45° field of view, color fundus image — 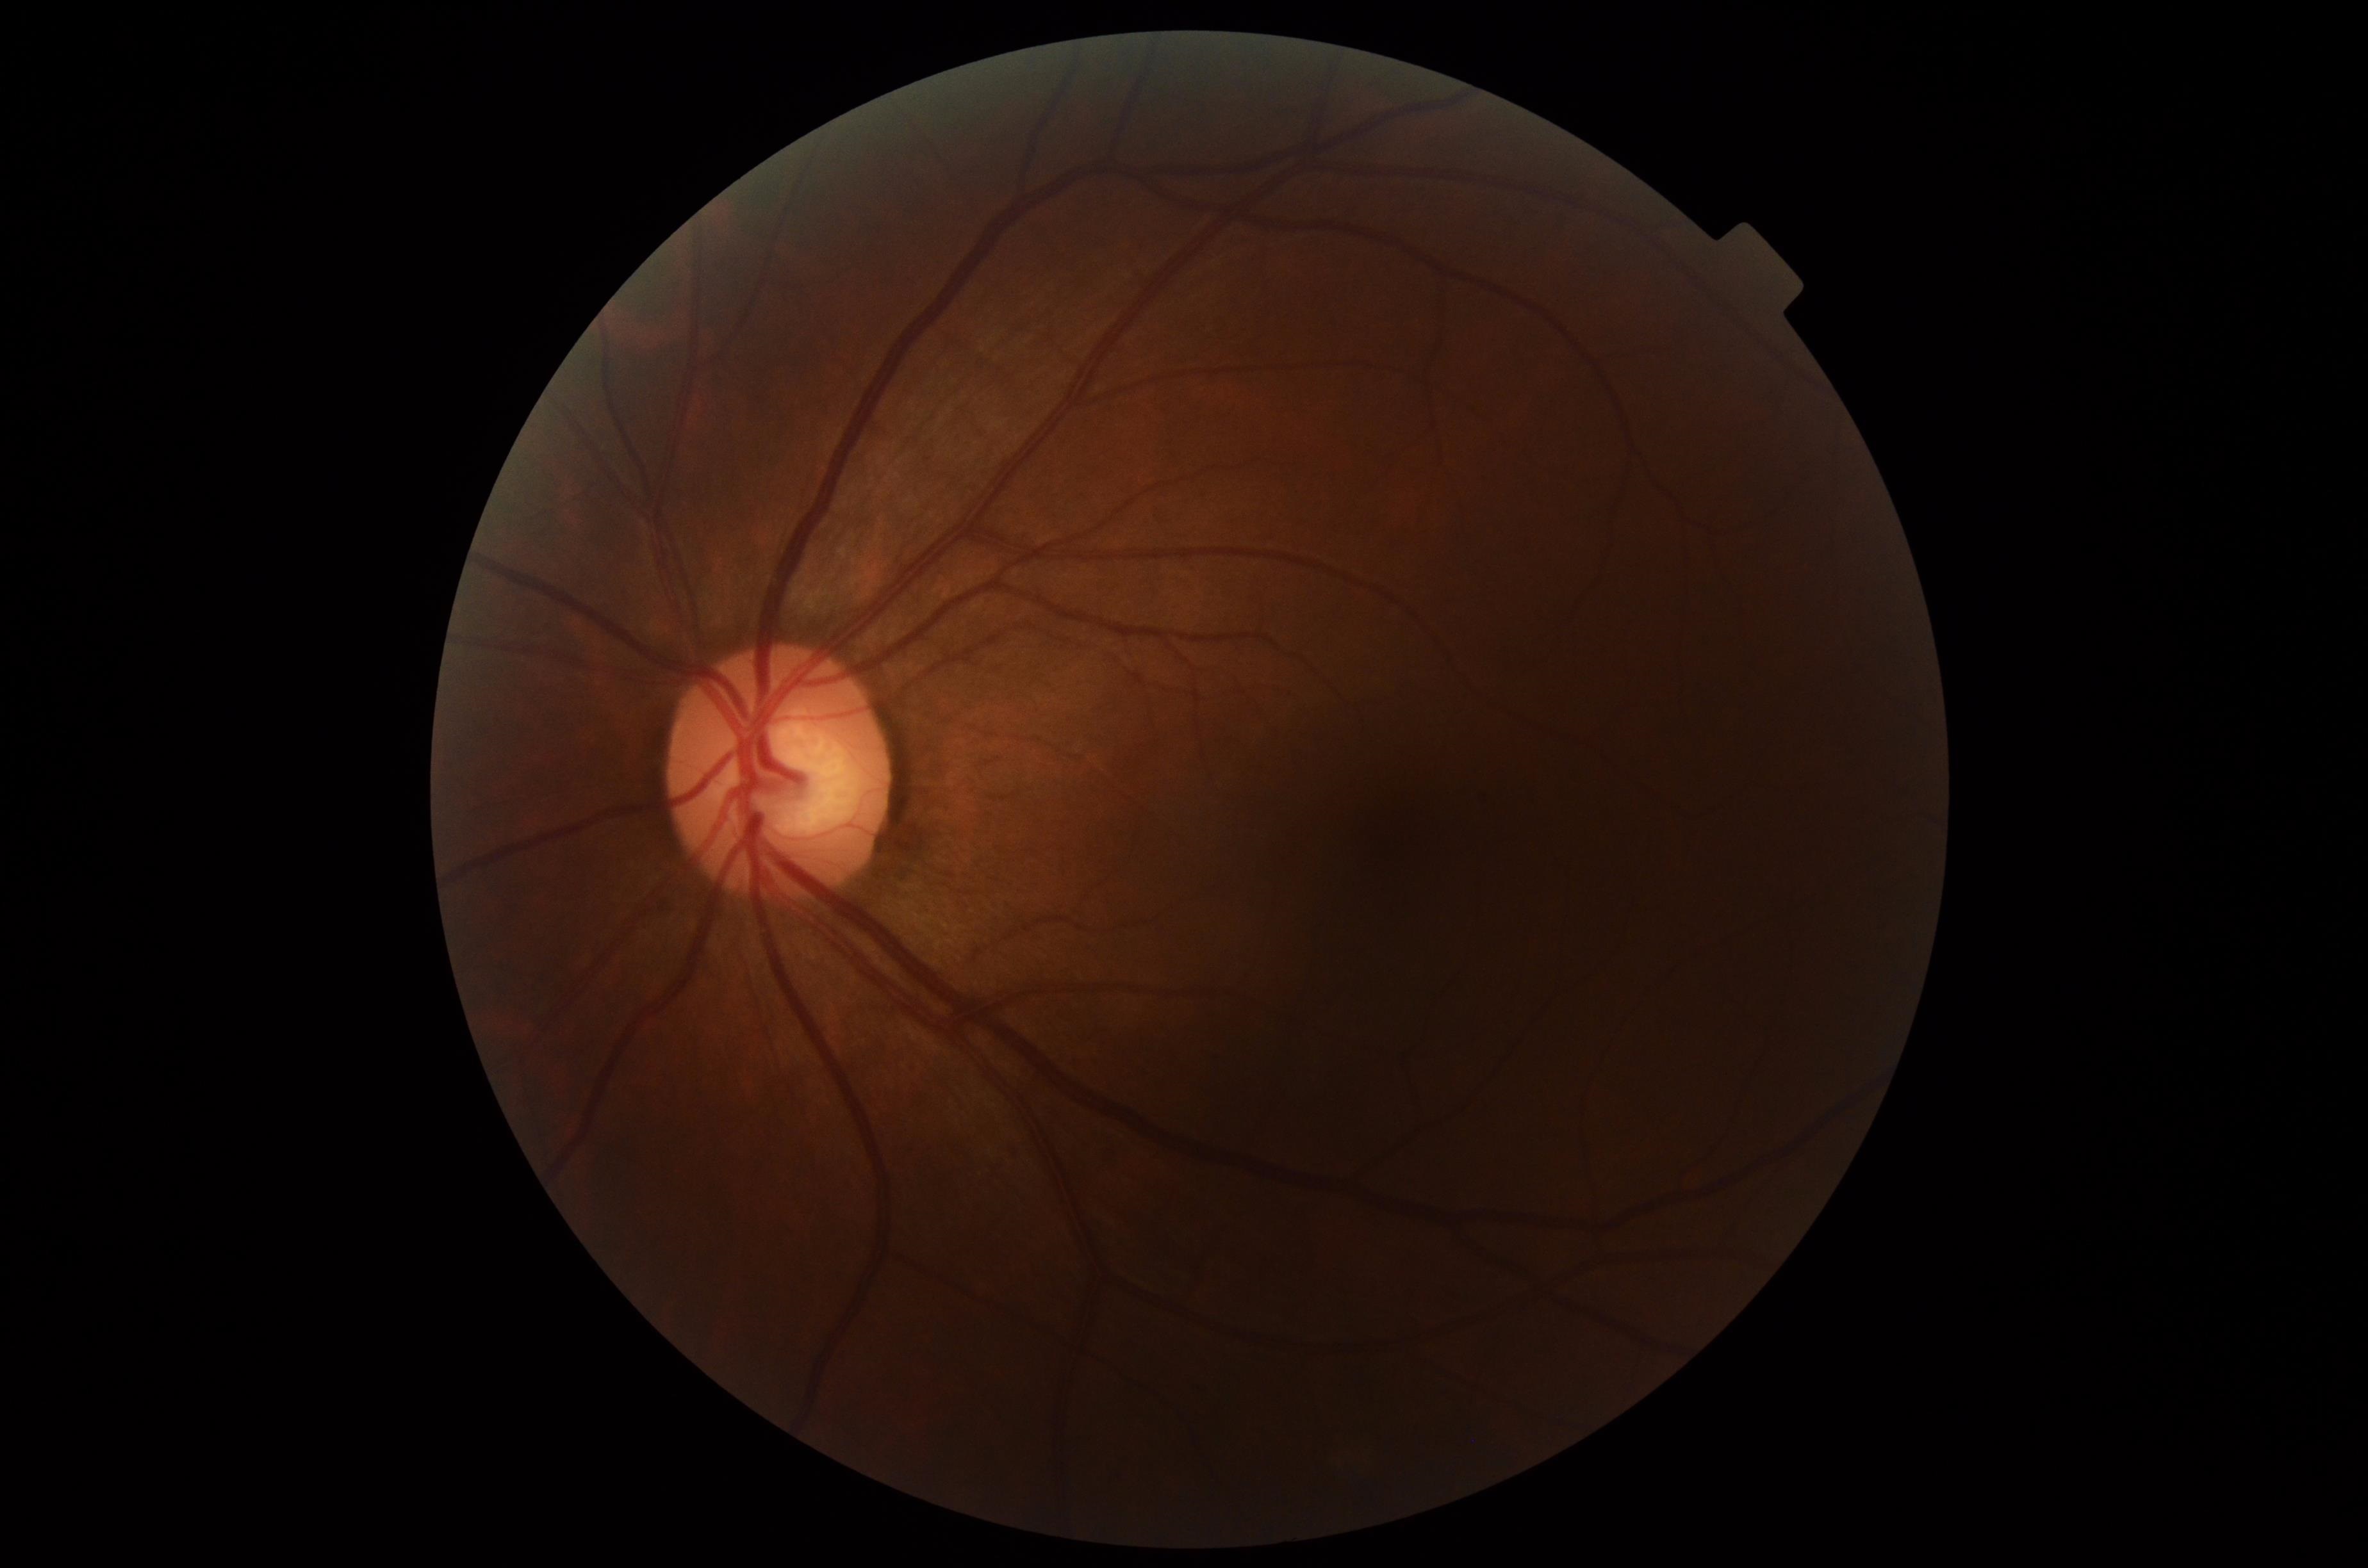

DR: grade 0 — no visible signs of diabetic retinopathy | DR impression: no DR findings.